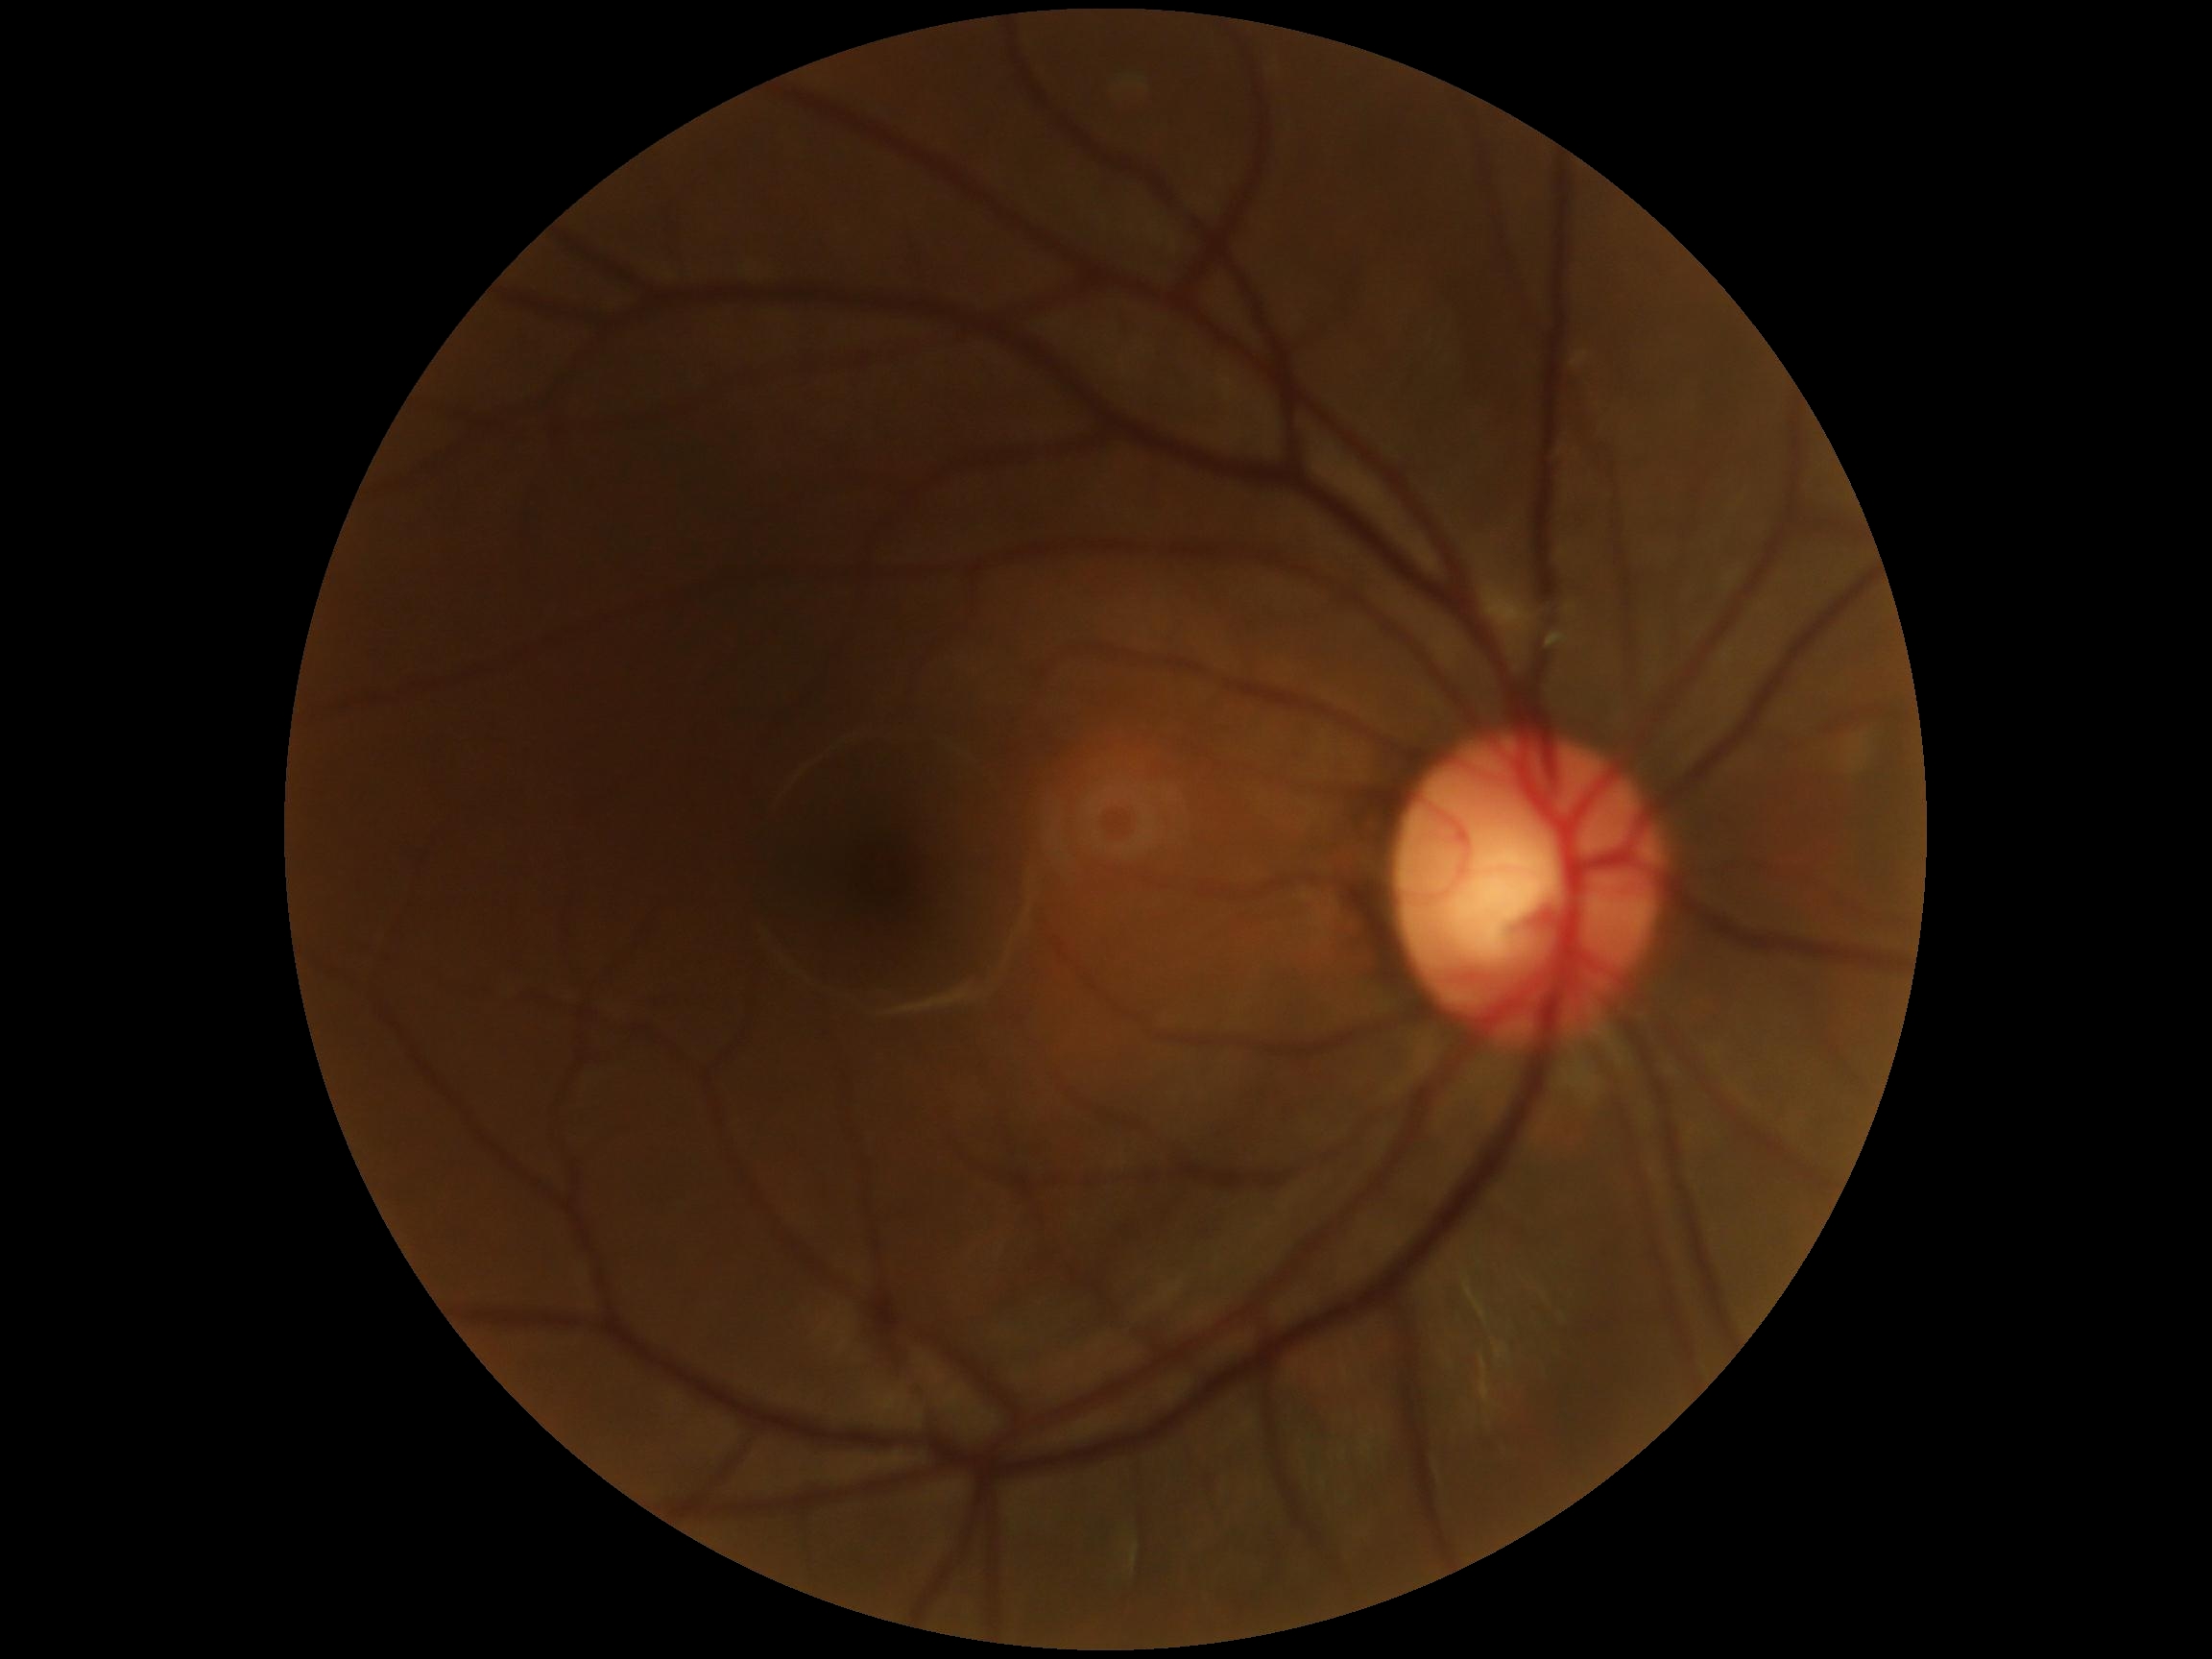

DR impression: no DR findings
diabetic retinopathy (DR): 0/4